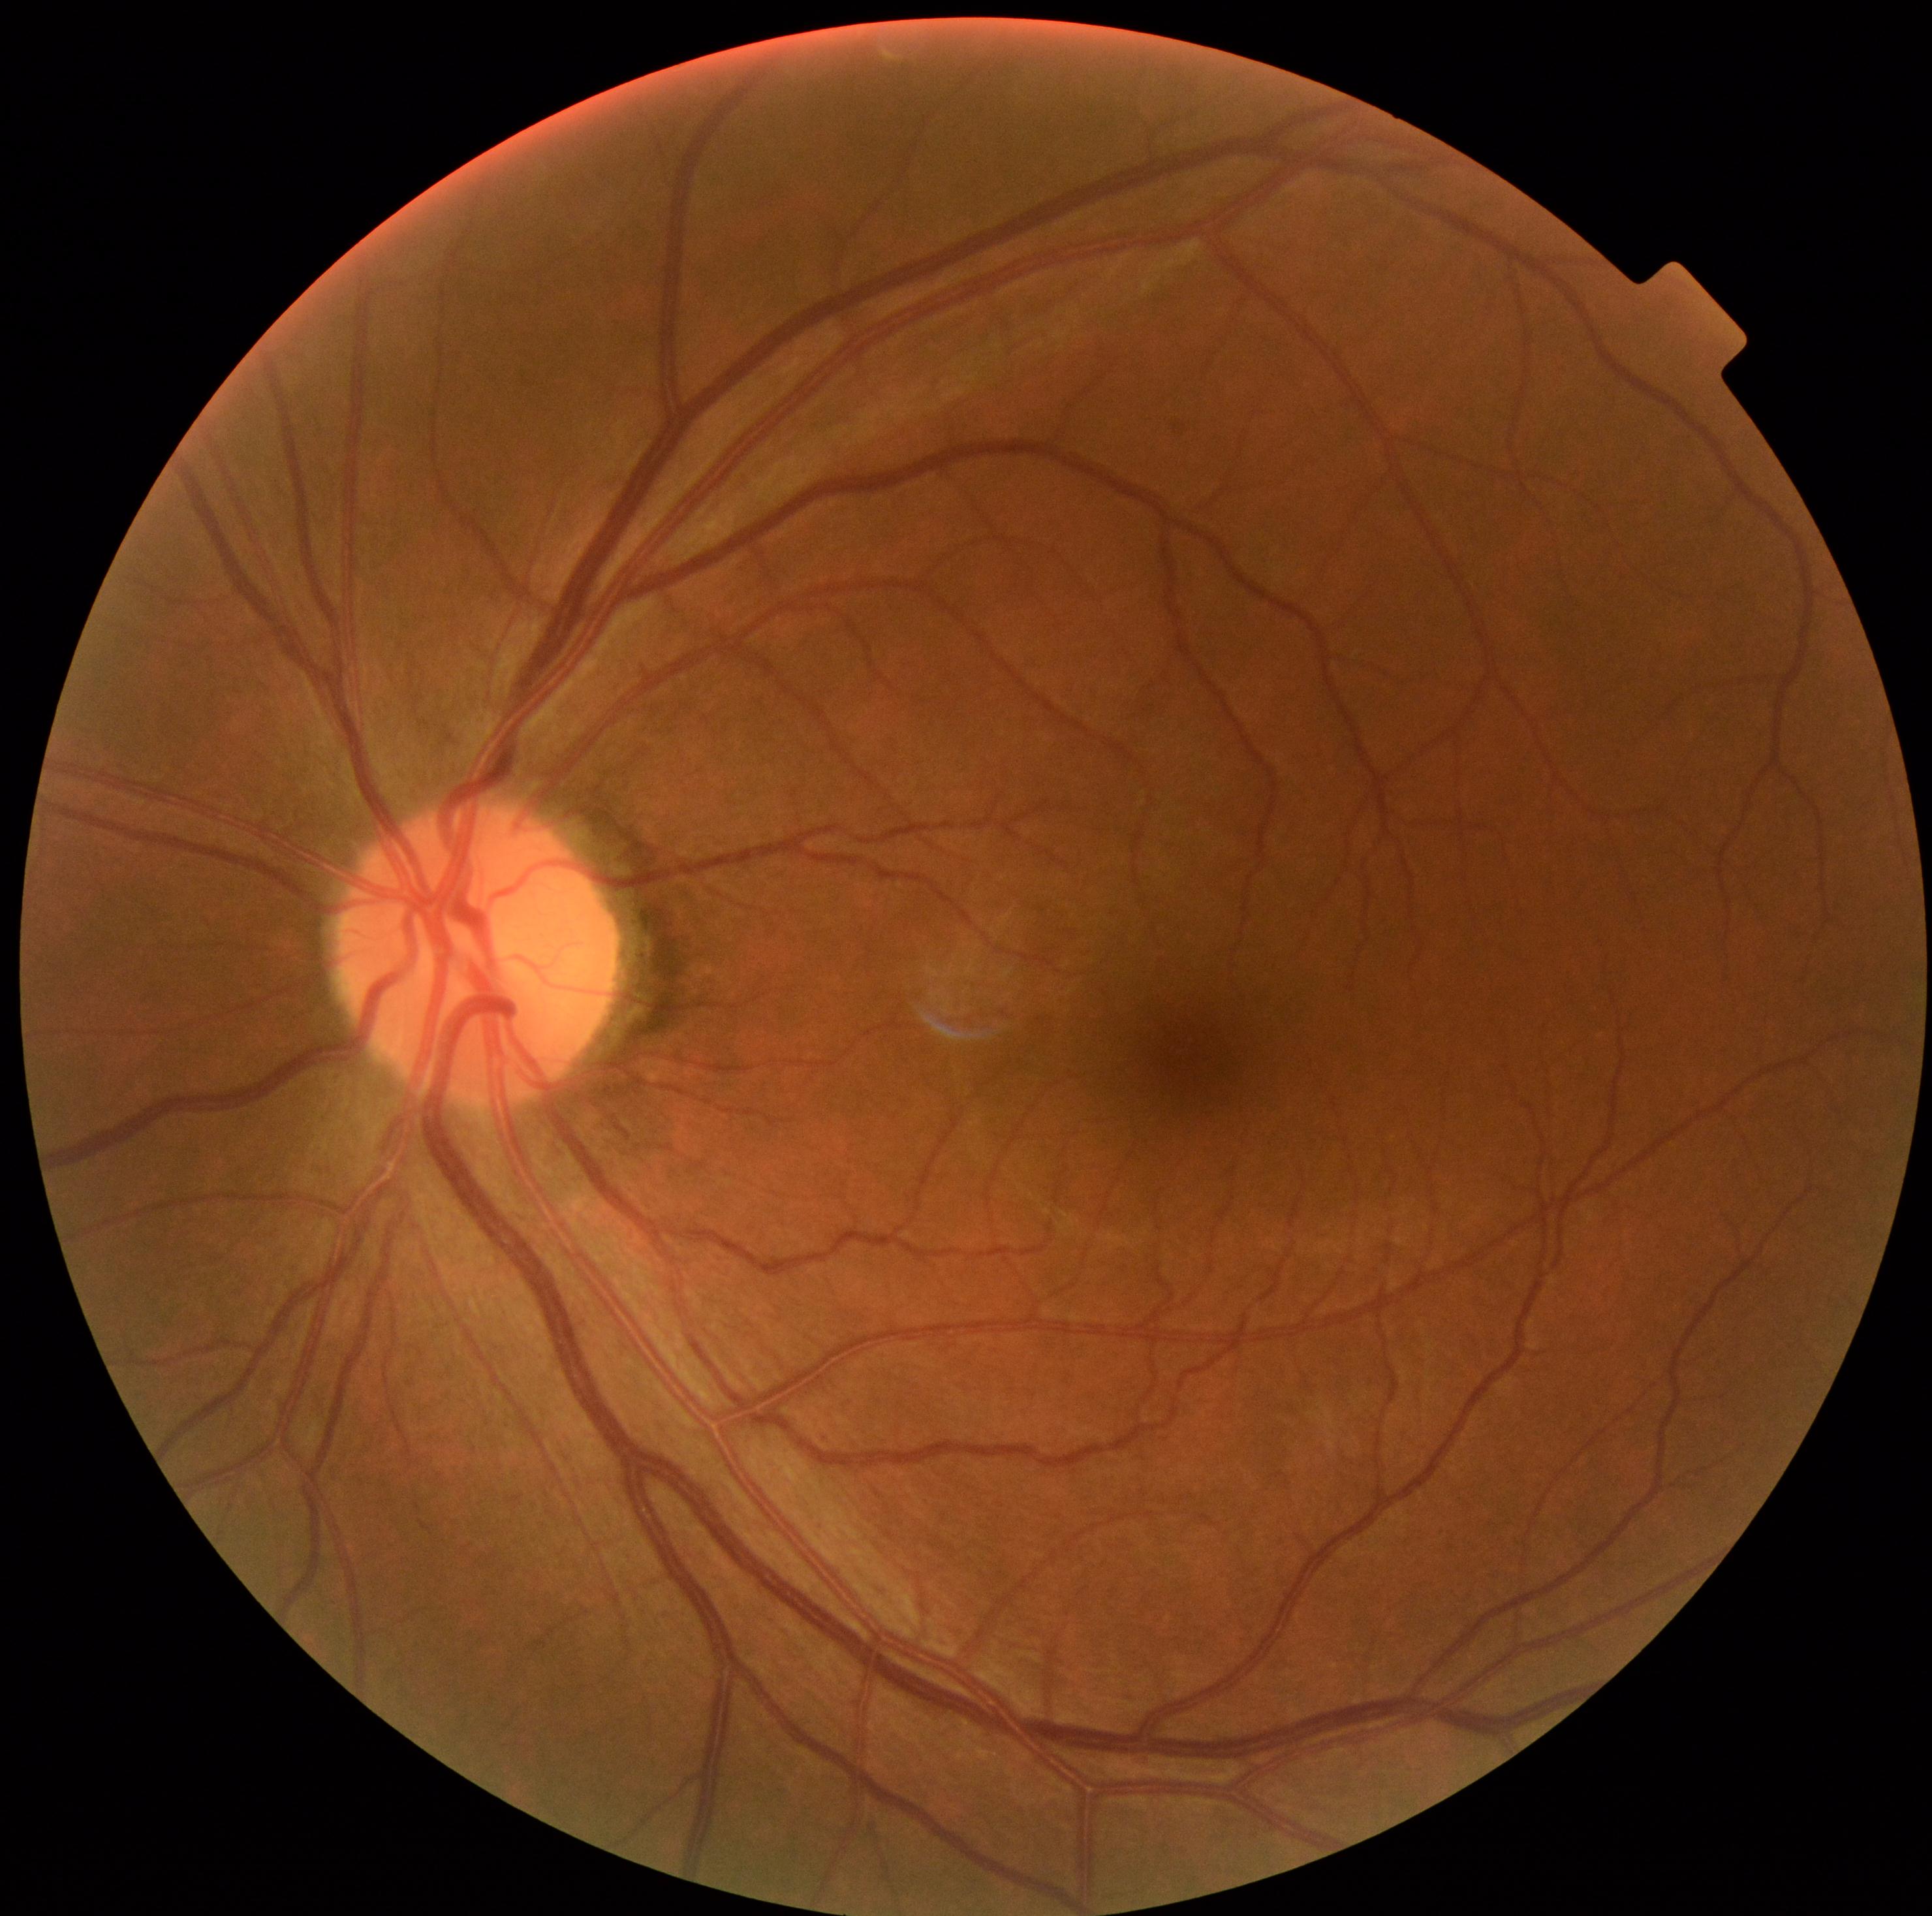
DR impression@no signs of DR; DR severity@0.